Wide-field fundus photograph from neonatal ROP screening — 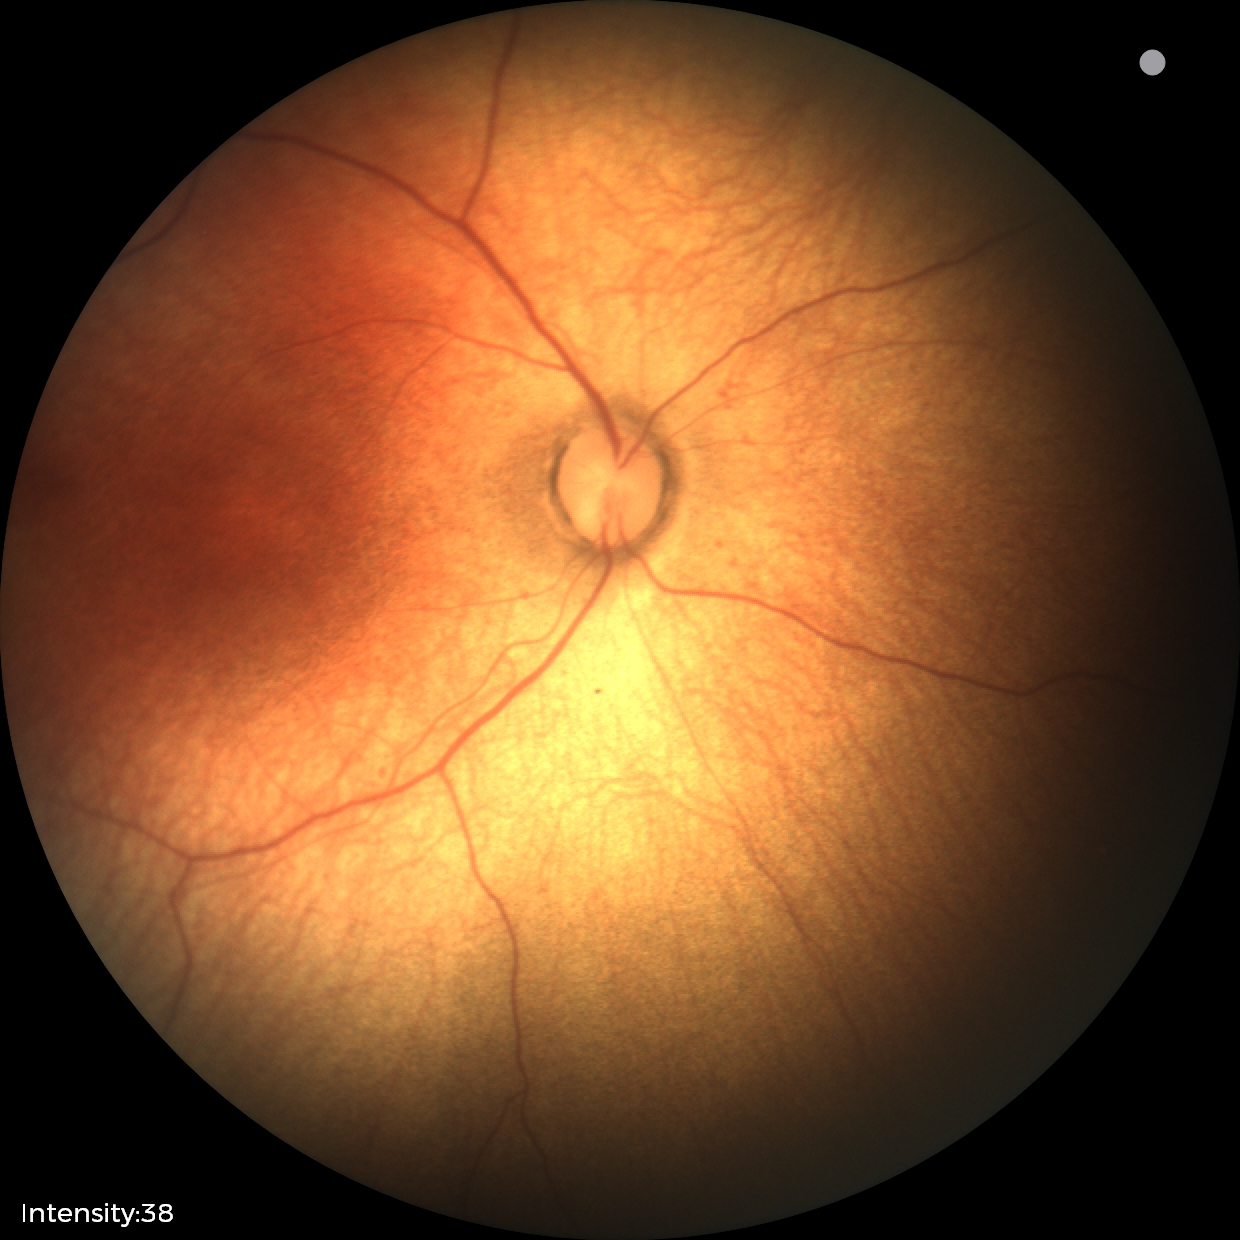
Normal screening examination.